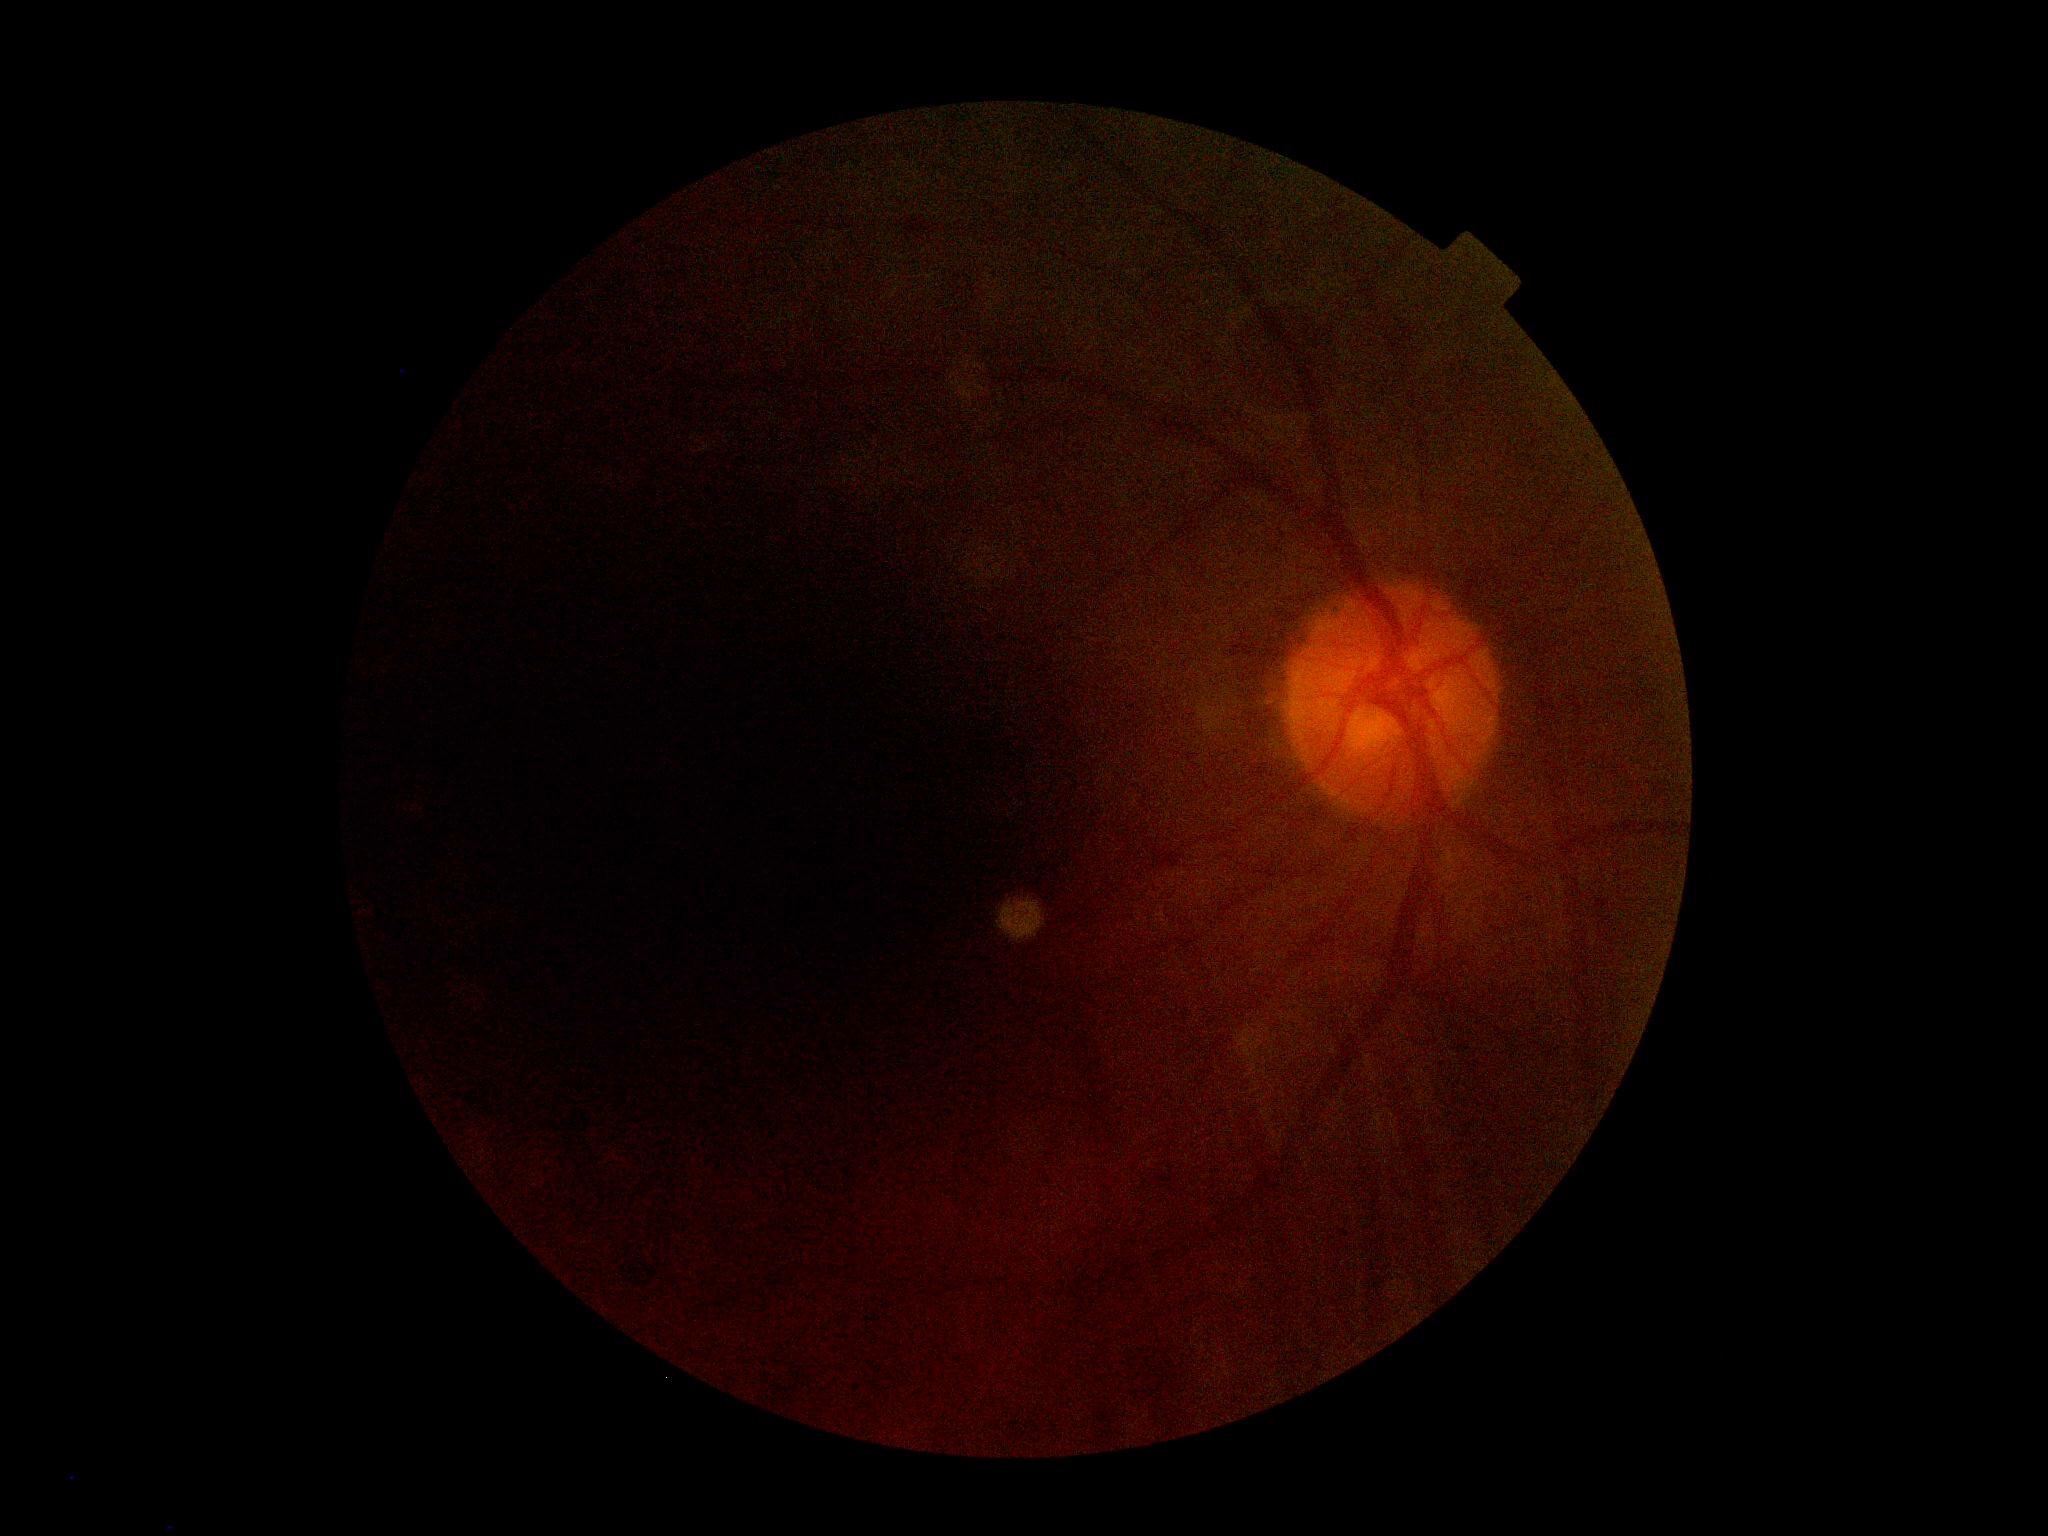 DR severity = ungradable.